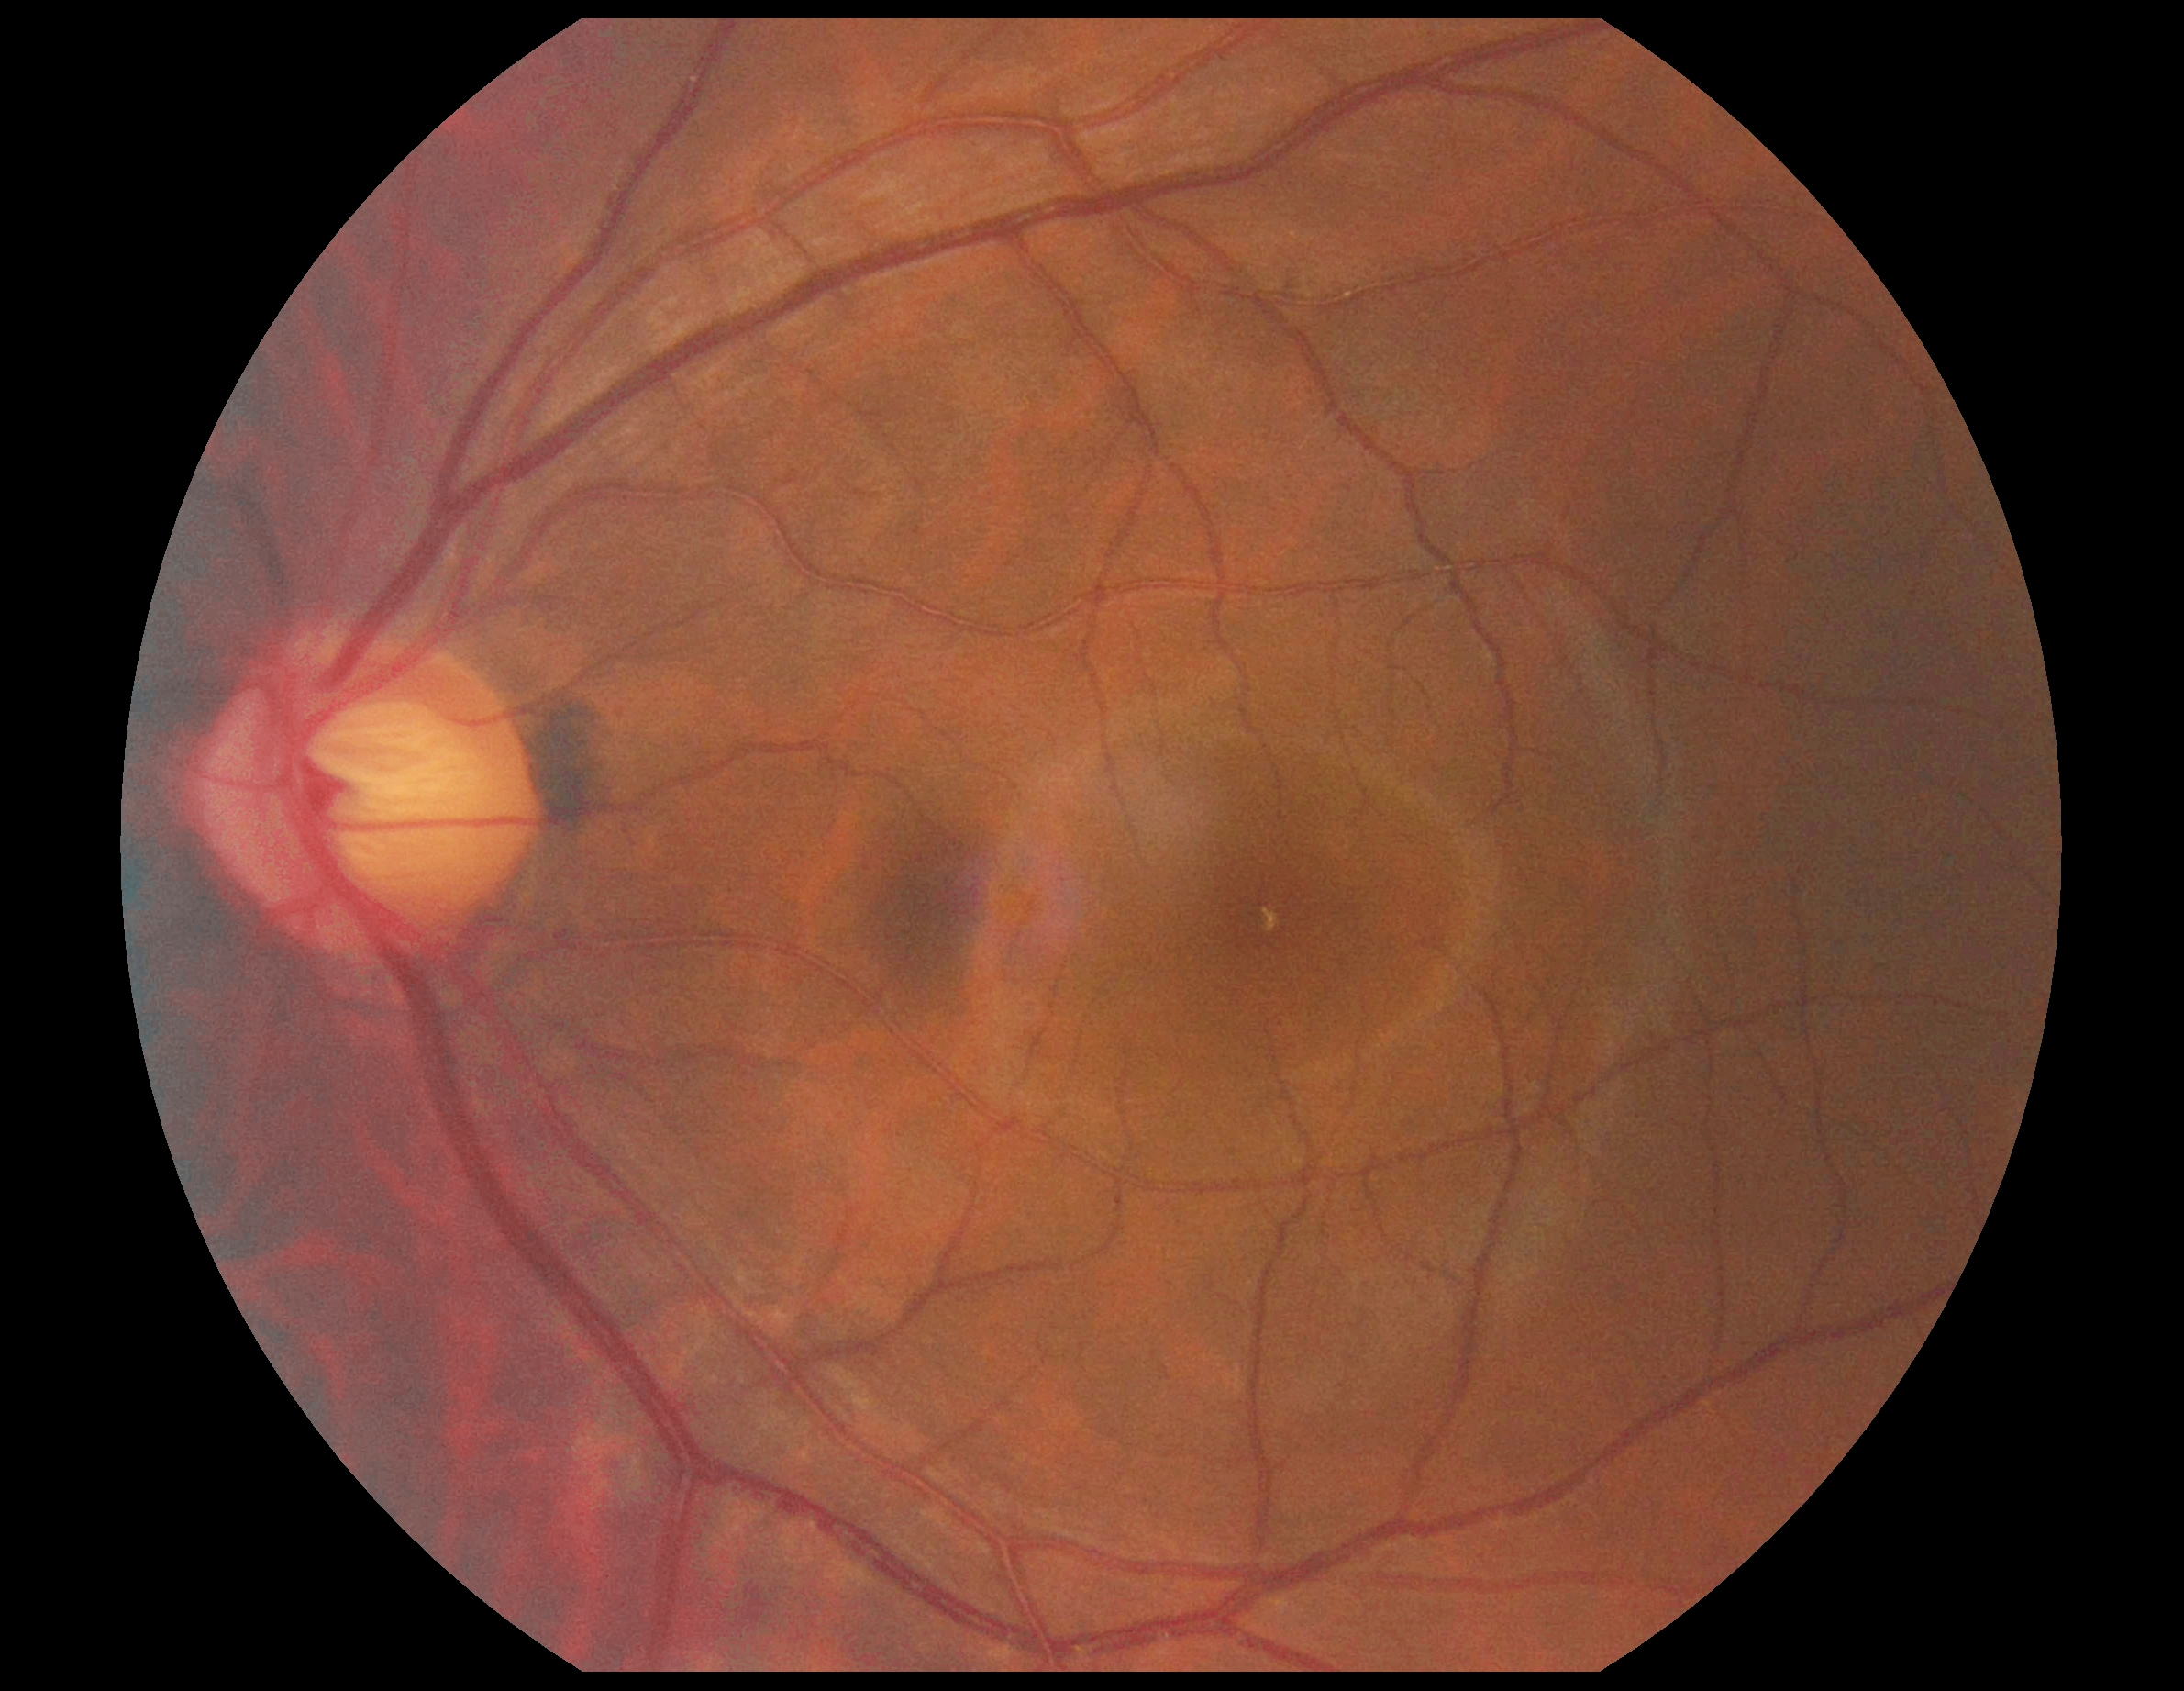
Findings:
• retinopathy: no apparent retinopathy (grade 0)